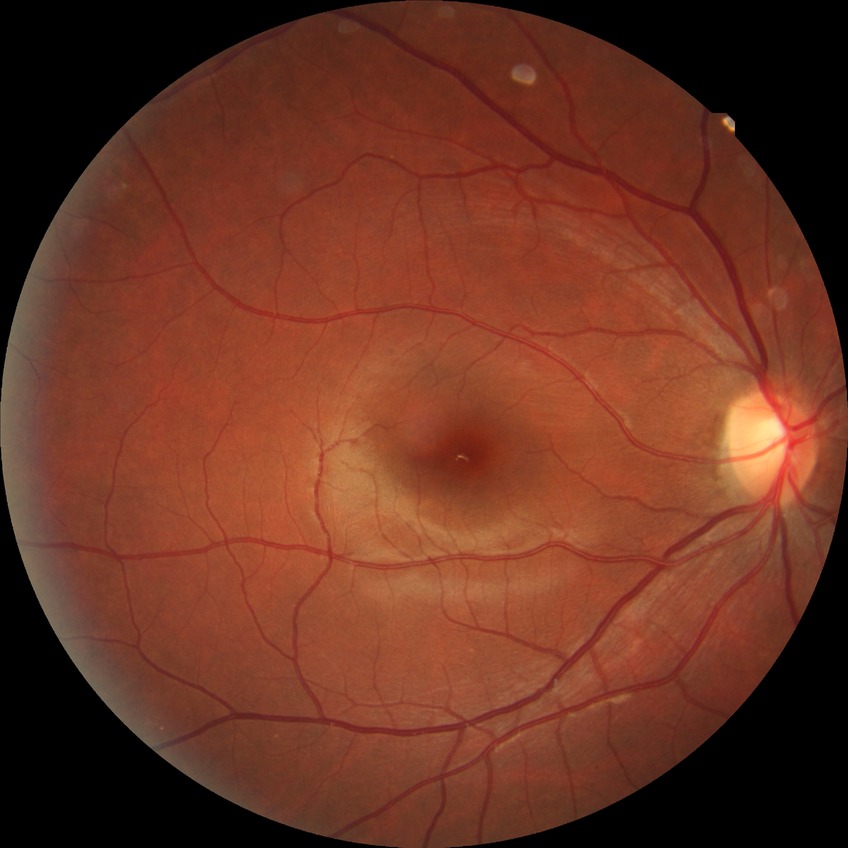

Modified Davis classification is no diabetic retinopathy.